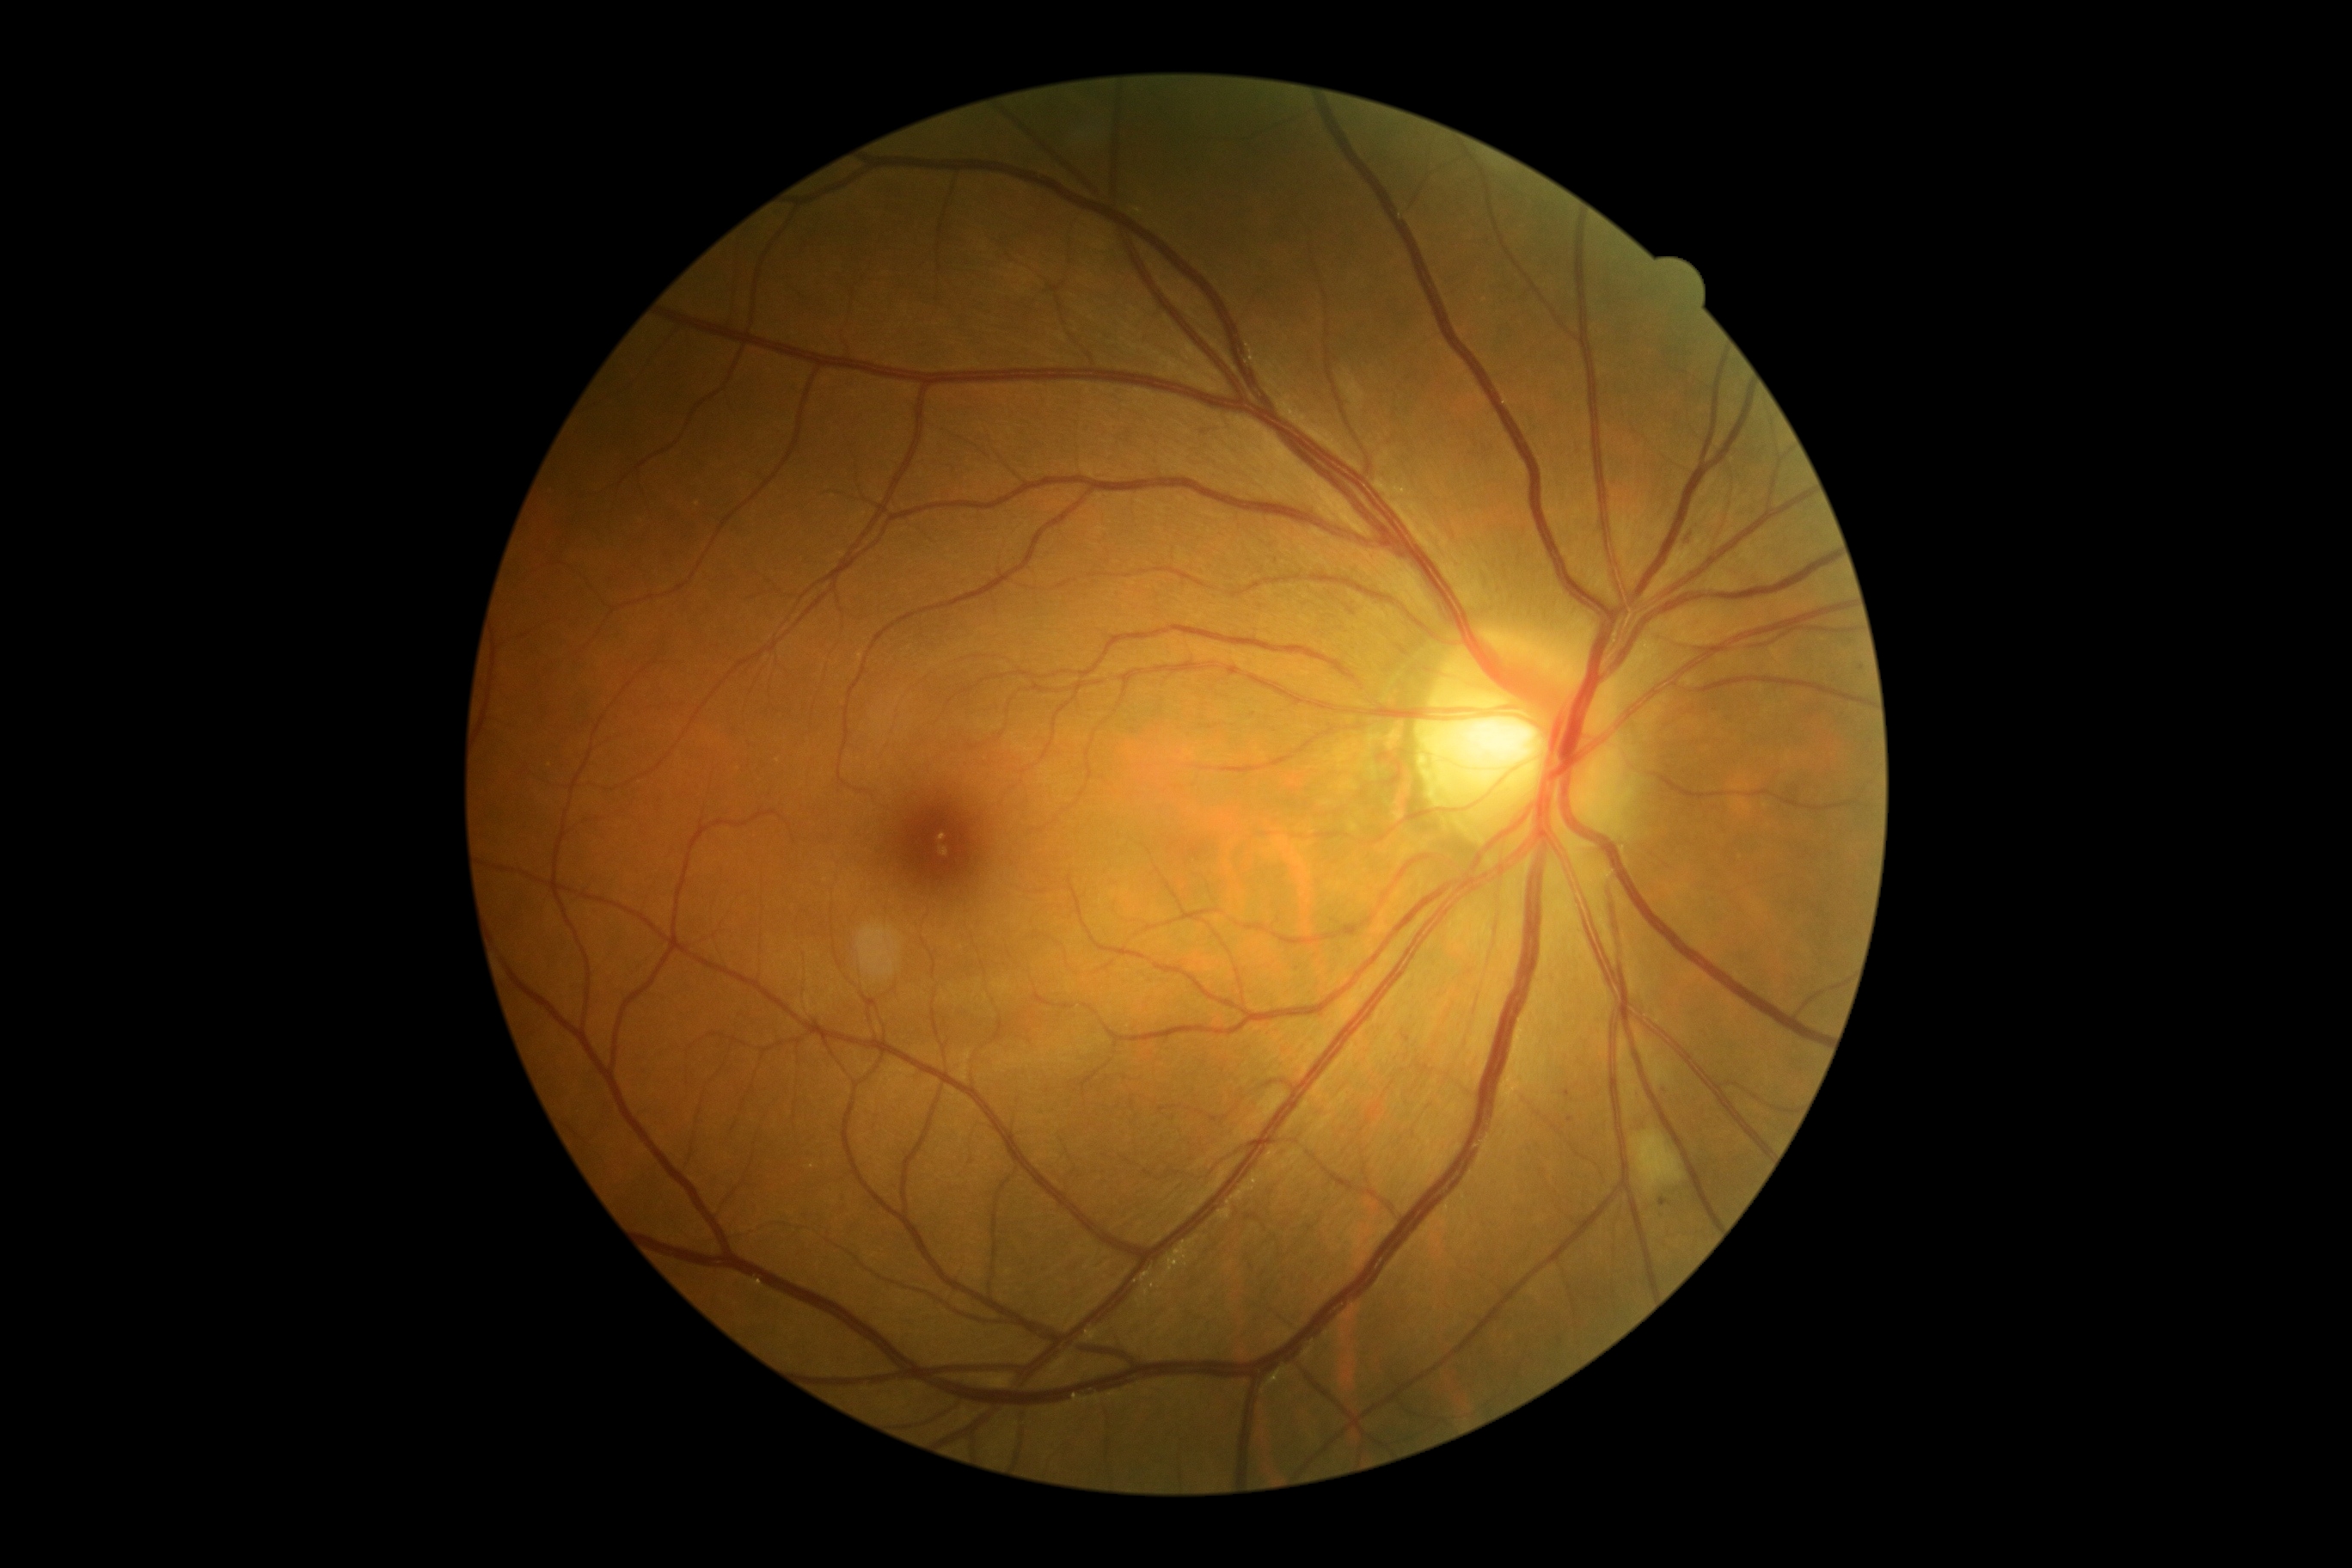
  dr_grade: grade 2